Diabetic retinopathy graded by the modified Davis classification:
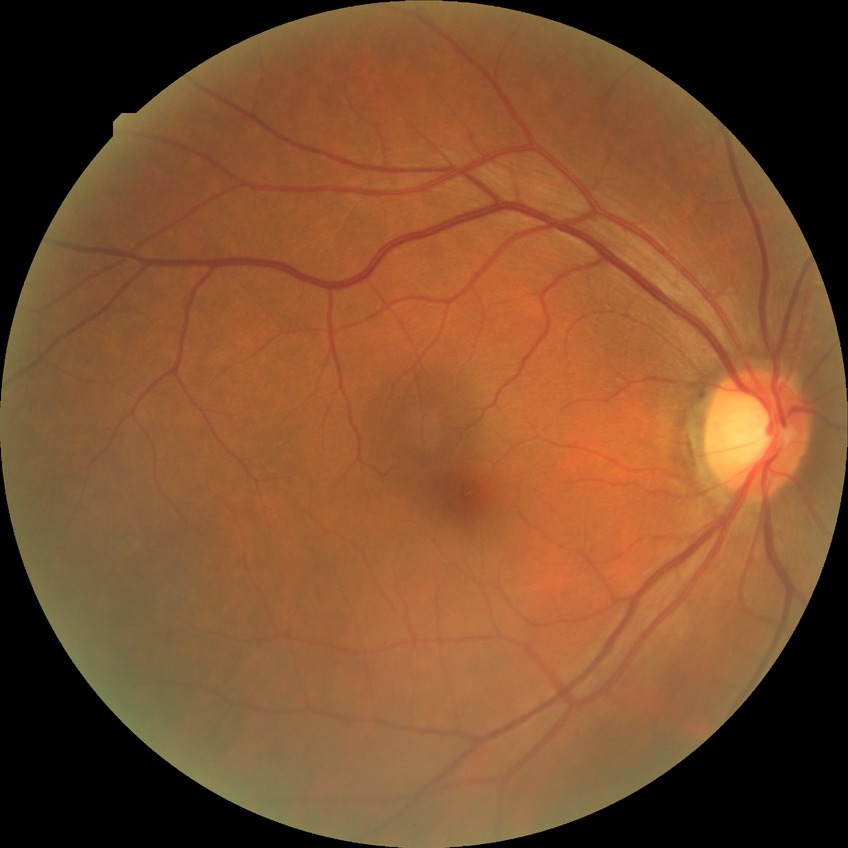
DR = NDR